Image size 848x848 · camera: NIDEK AFC-230
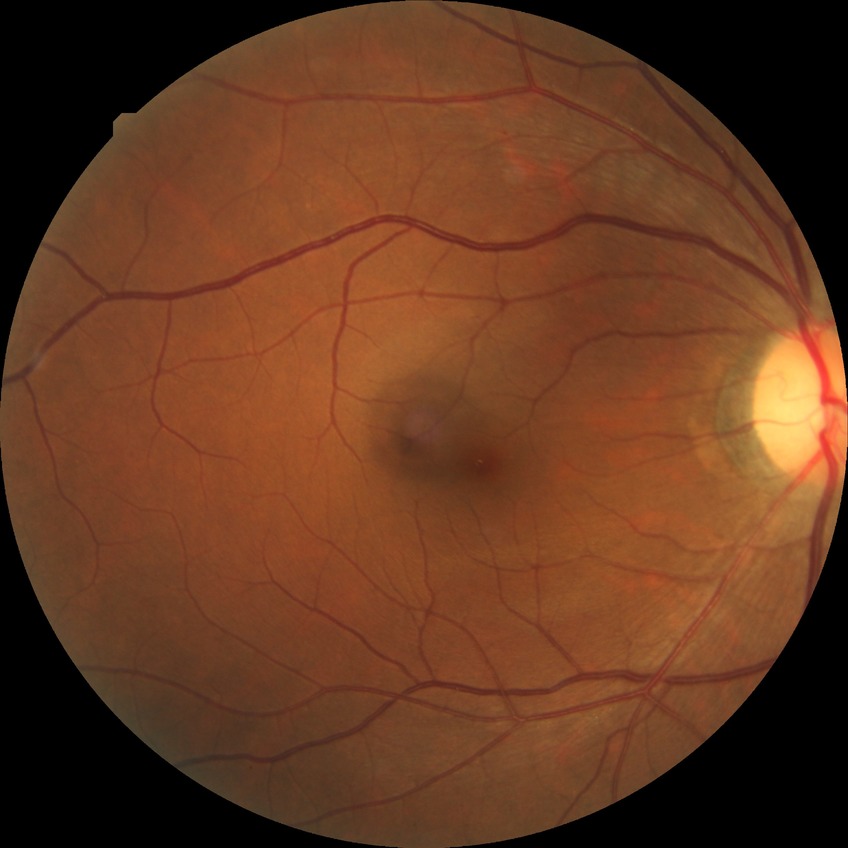
Diabetic retinopathy (DR) is NDR (no diabetic retinopathy).